640x480 · wide-field contact fundus photograph of an infant · Clarity RetCam 3, 130° FOV.
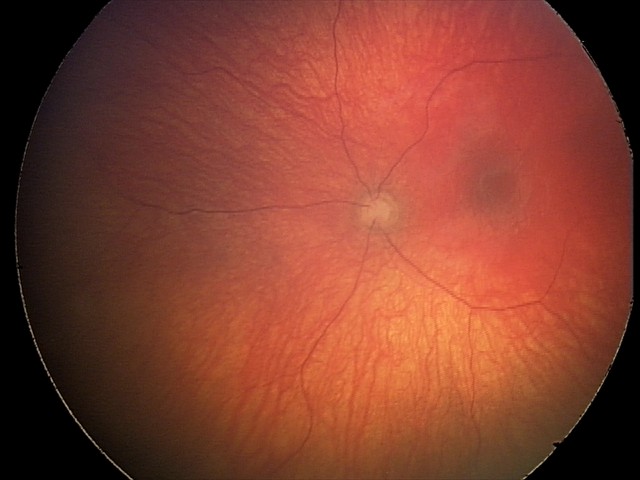
Assessment: optic nerve hypoplasia.